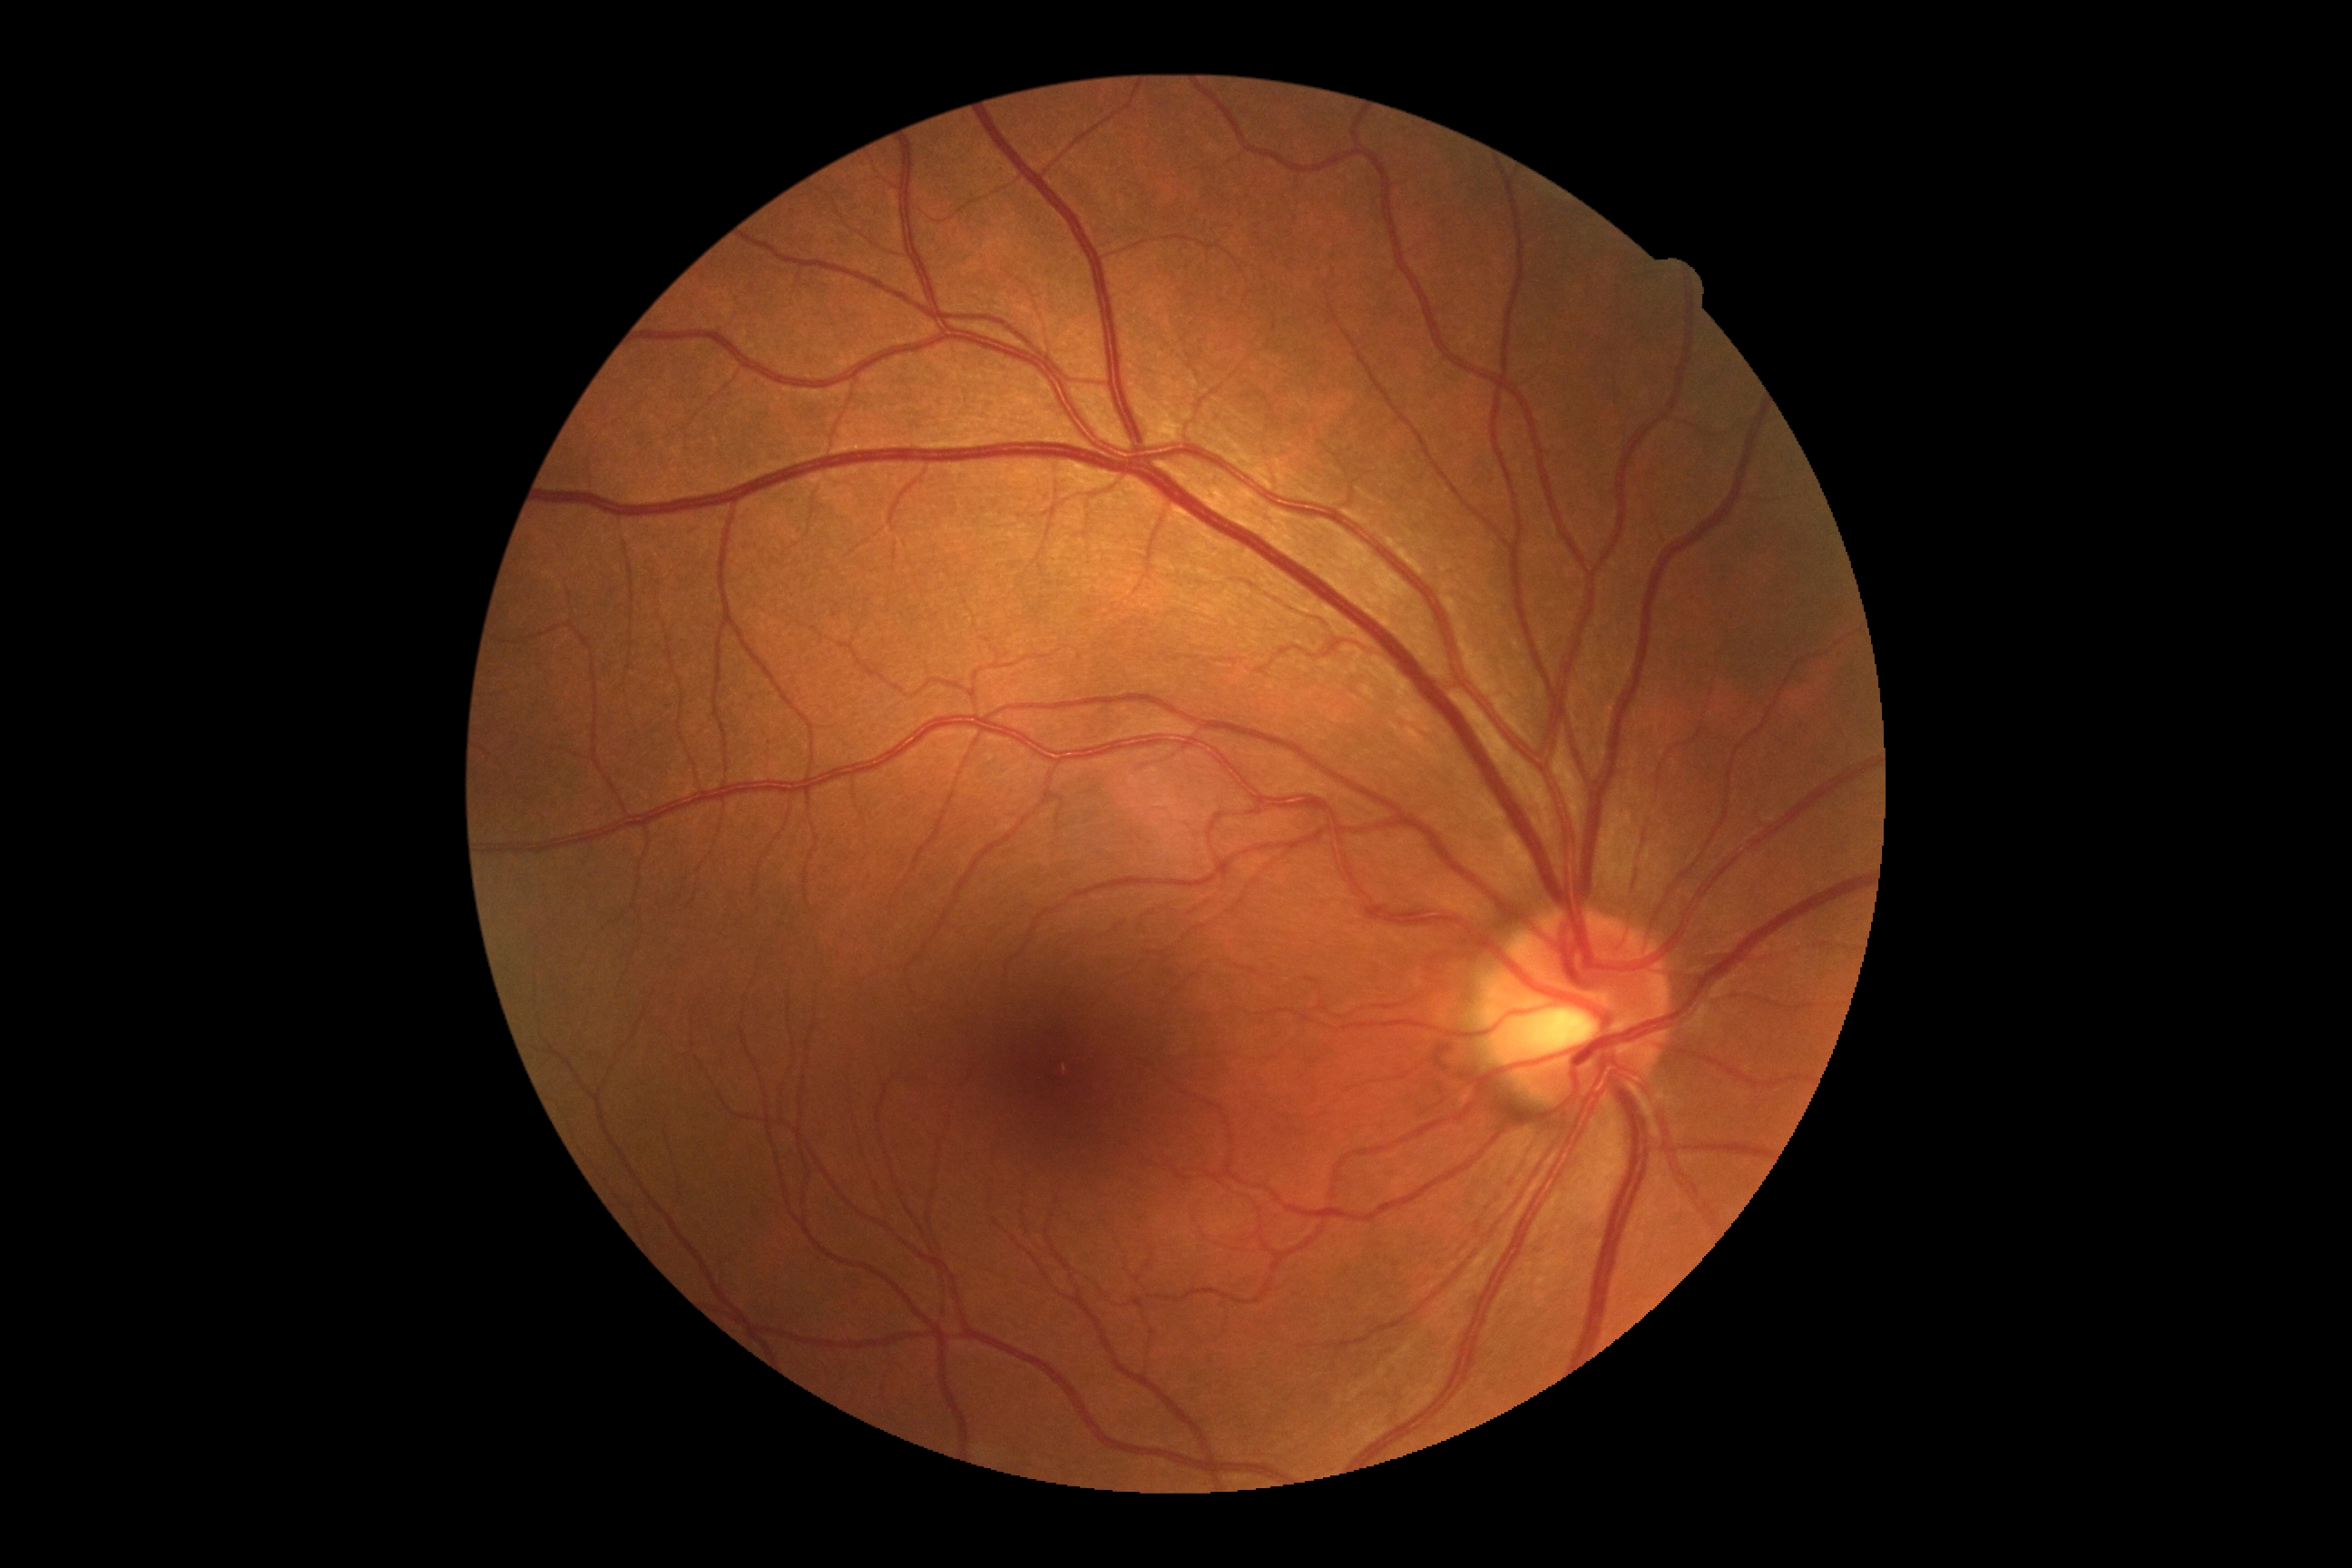

DR stage: grade 0 (no apparent retinopathy).